45° field of view. Retinal fundus photograph: 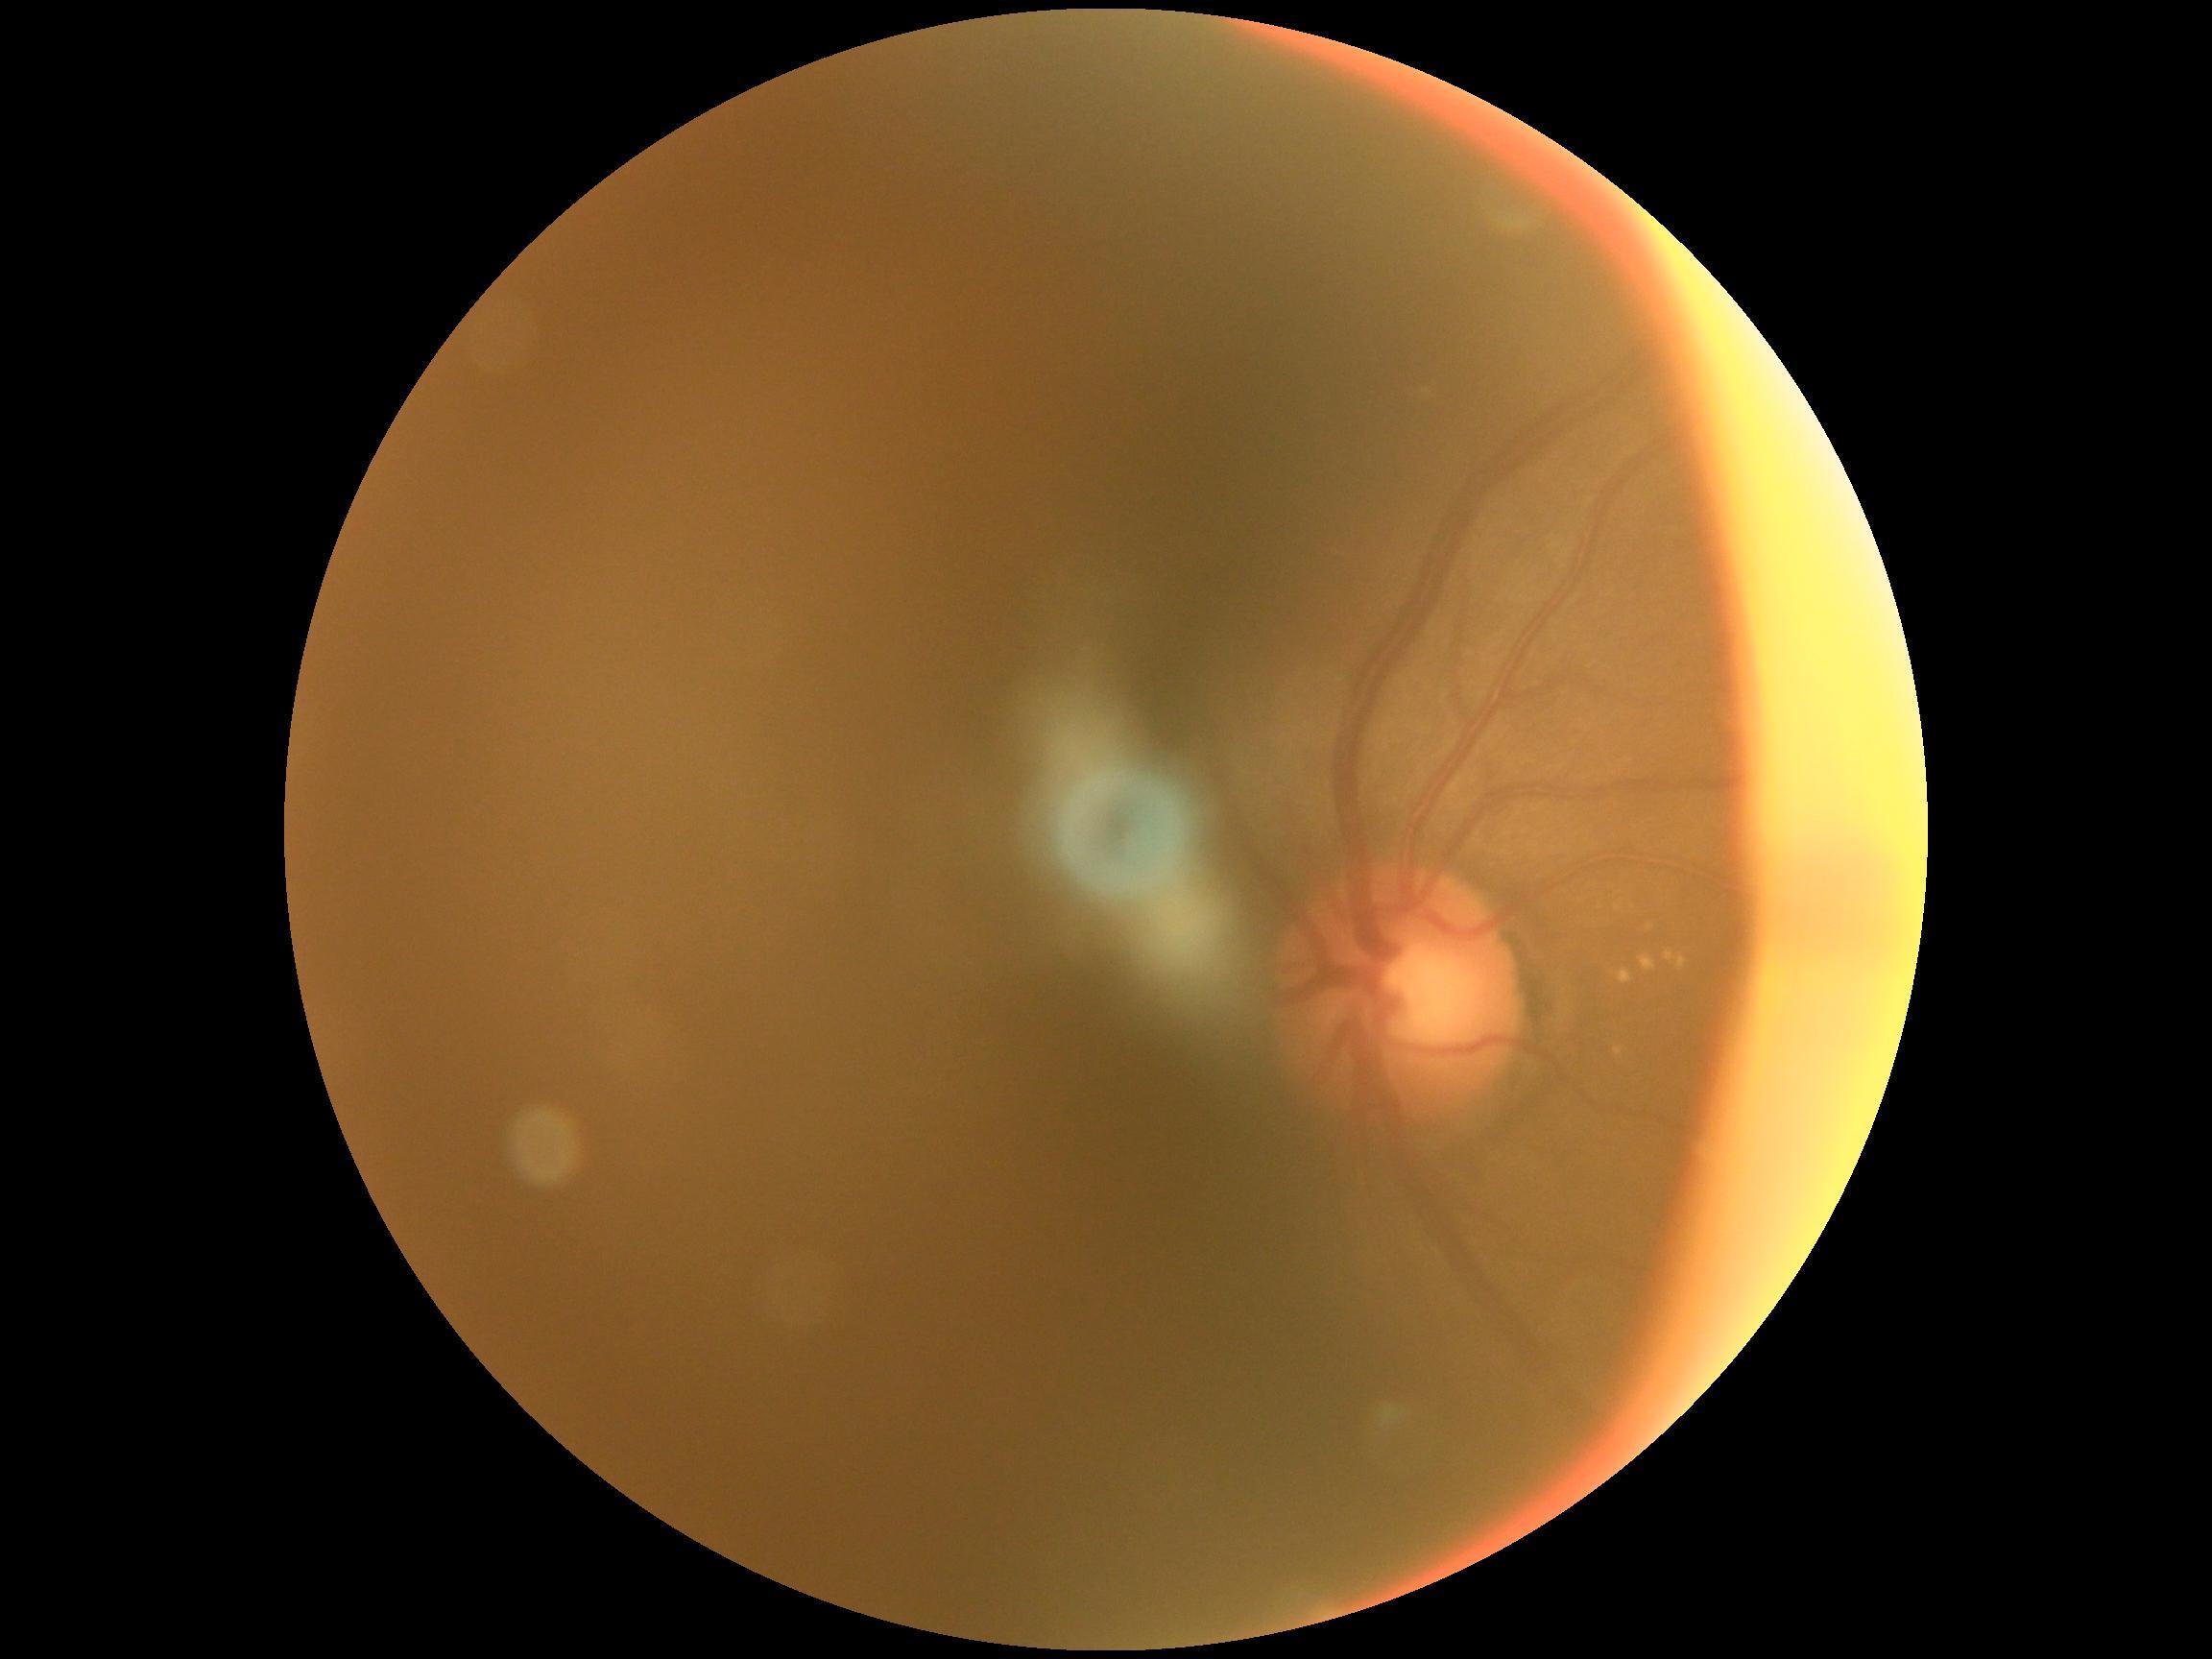 DR = ungradable.